Davis DR grading:
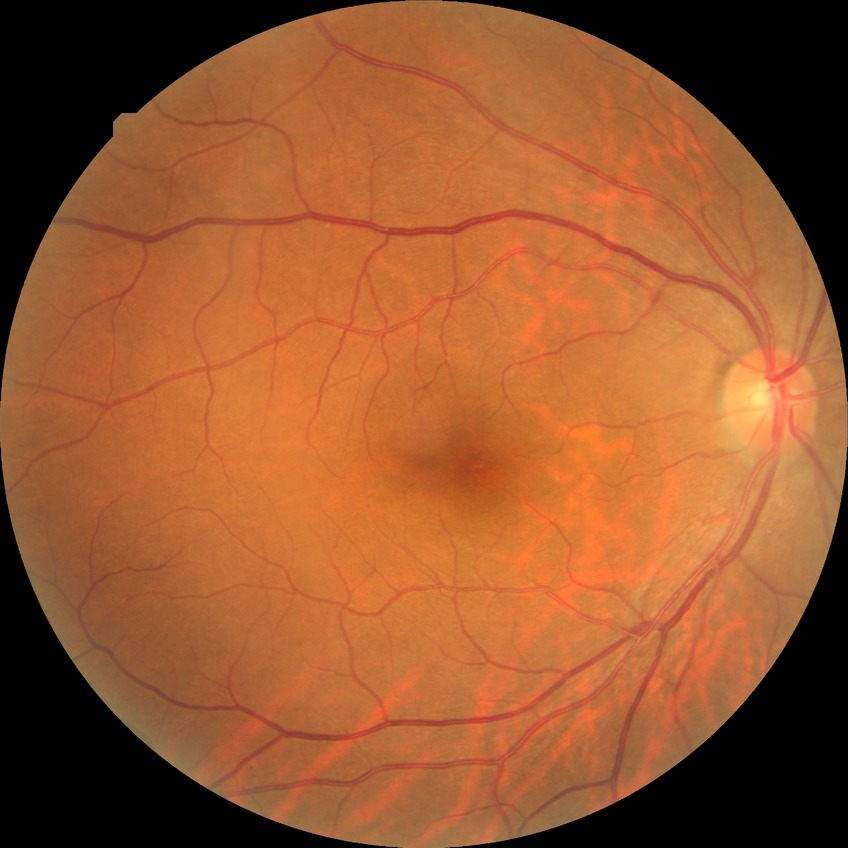
diabetic retinopathy (DR): NDR (no diabetic retinopathy).